Infant wide-field retinal image; Natus RetCam Envision, 130° FOV: 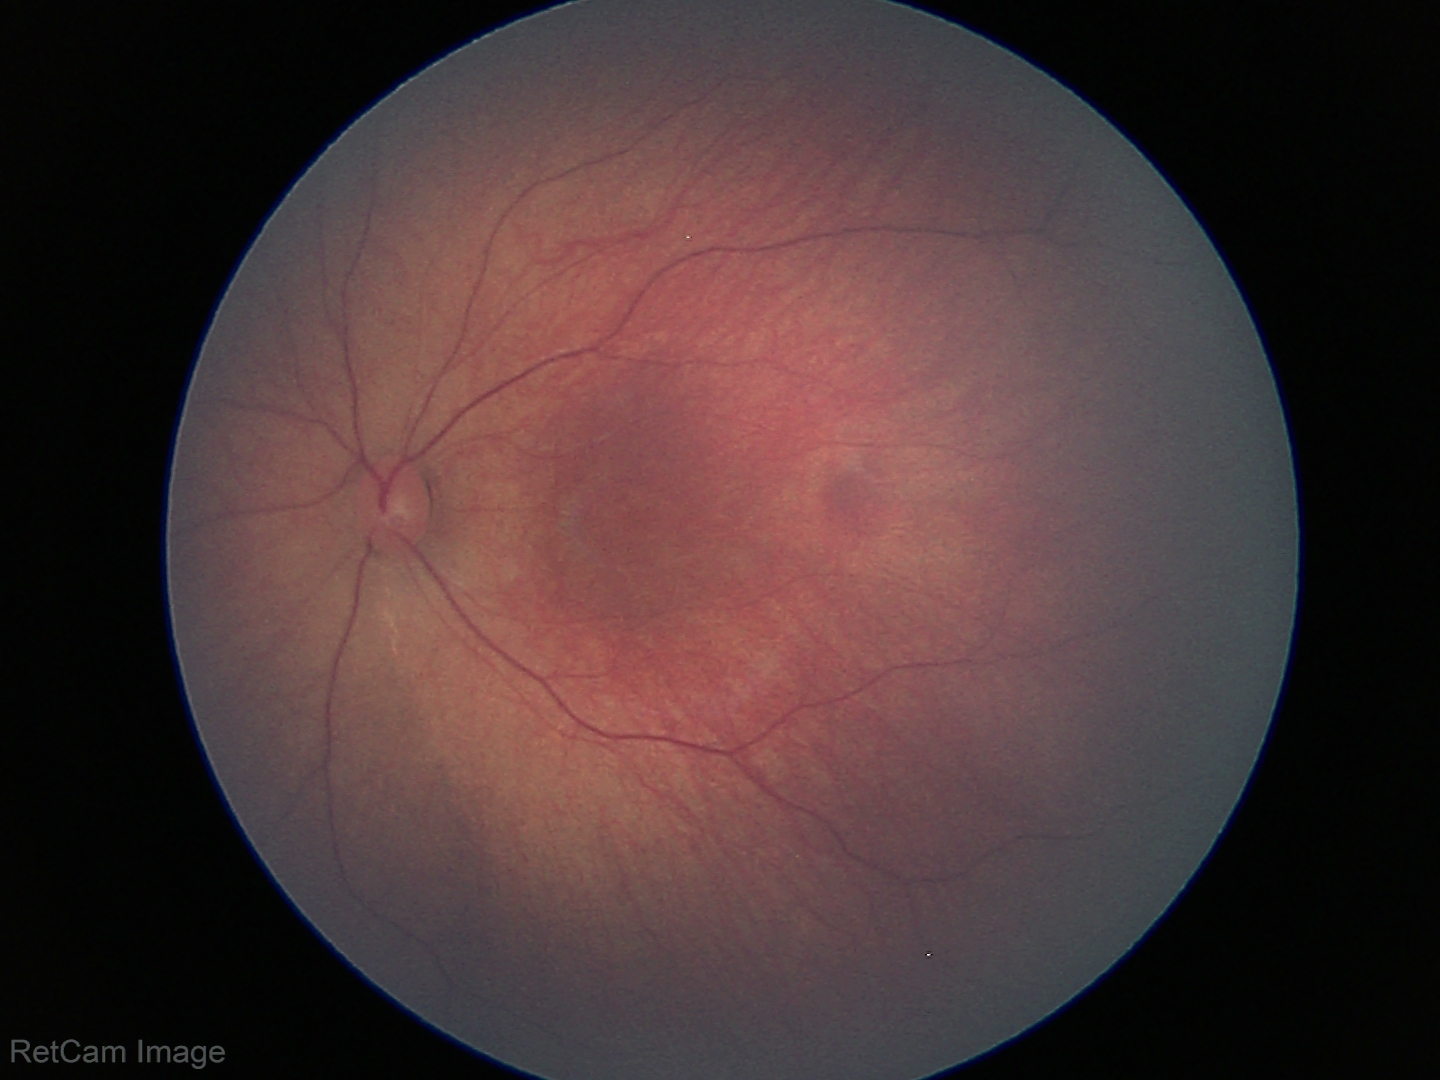 Impression: physiological finding.